FOV: 45 degrees · 2048 by 1536 pixels: 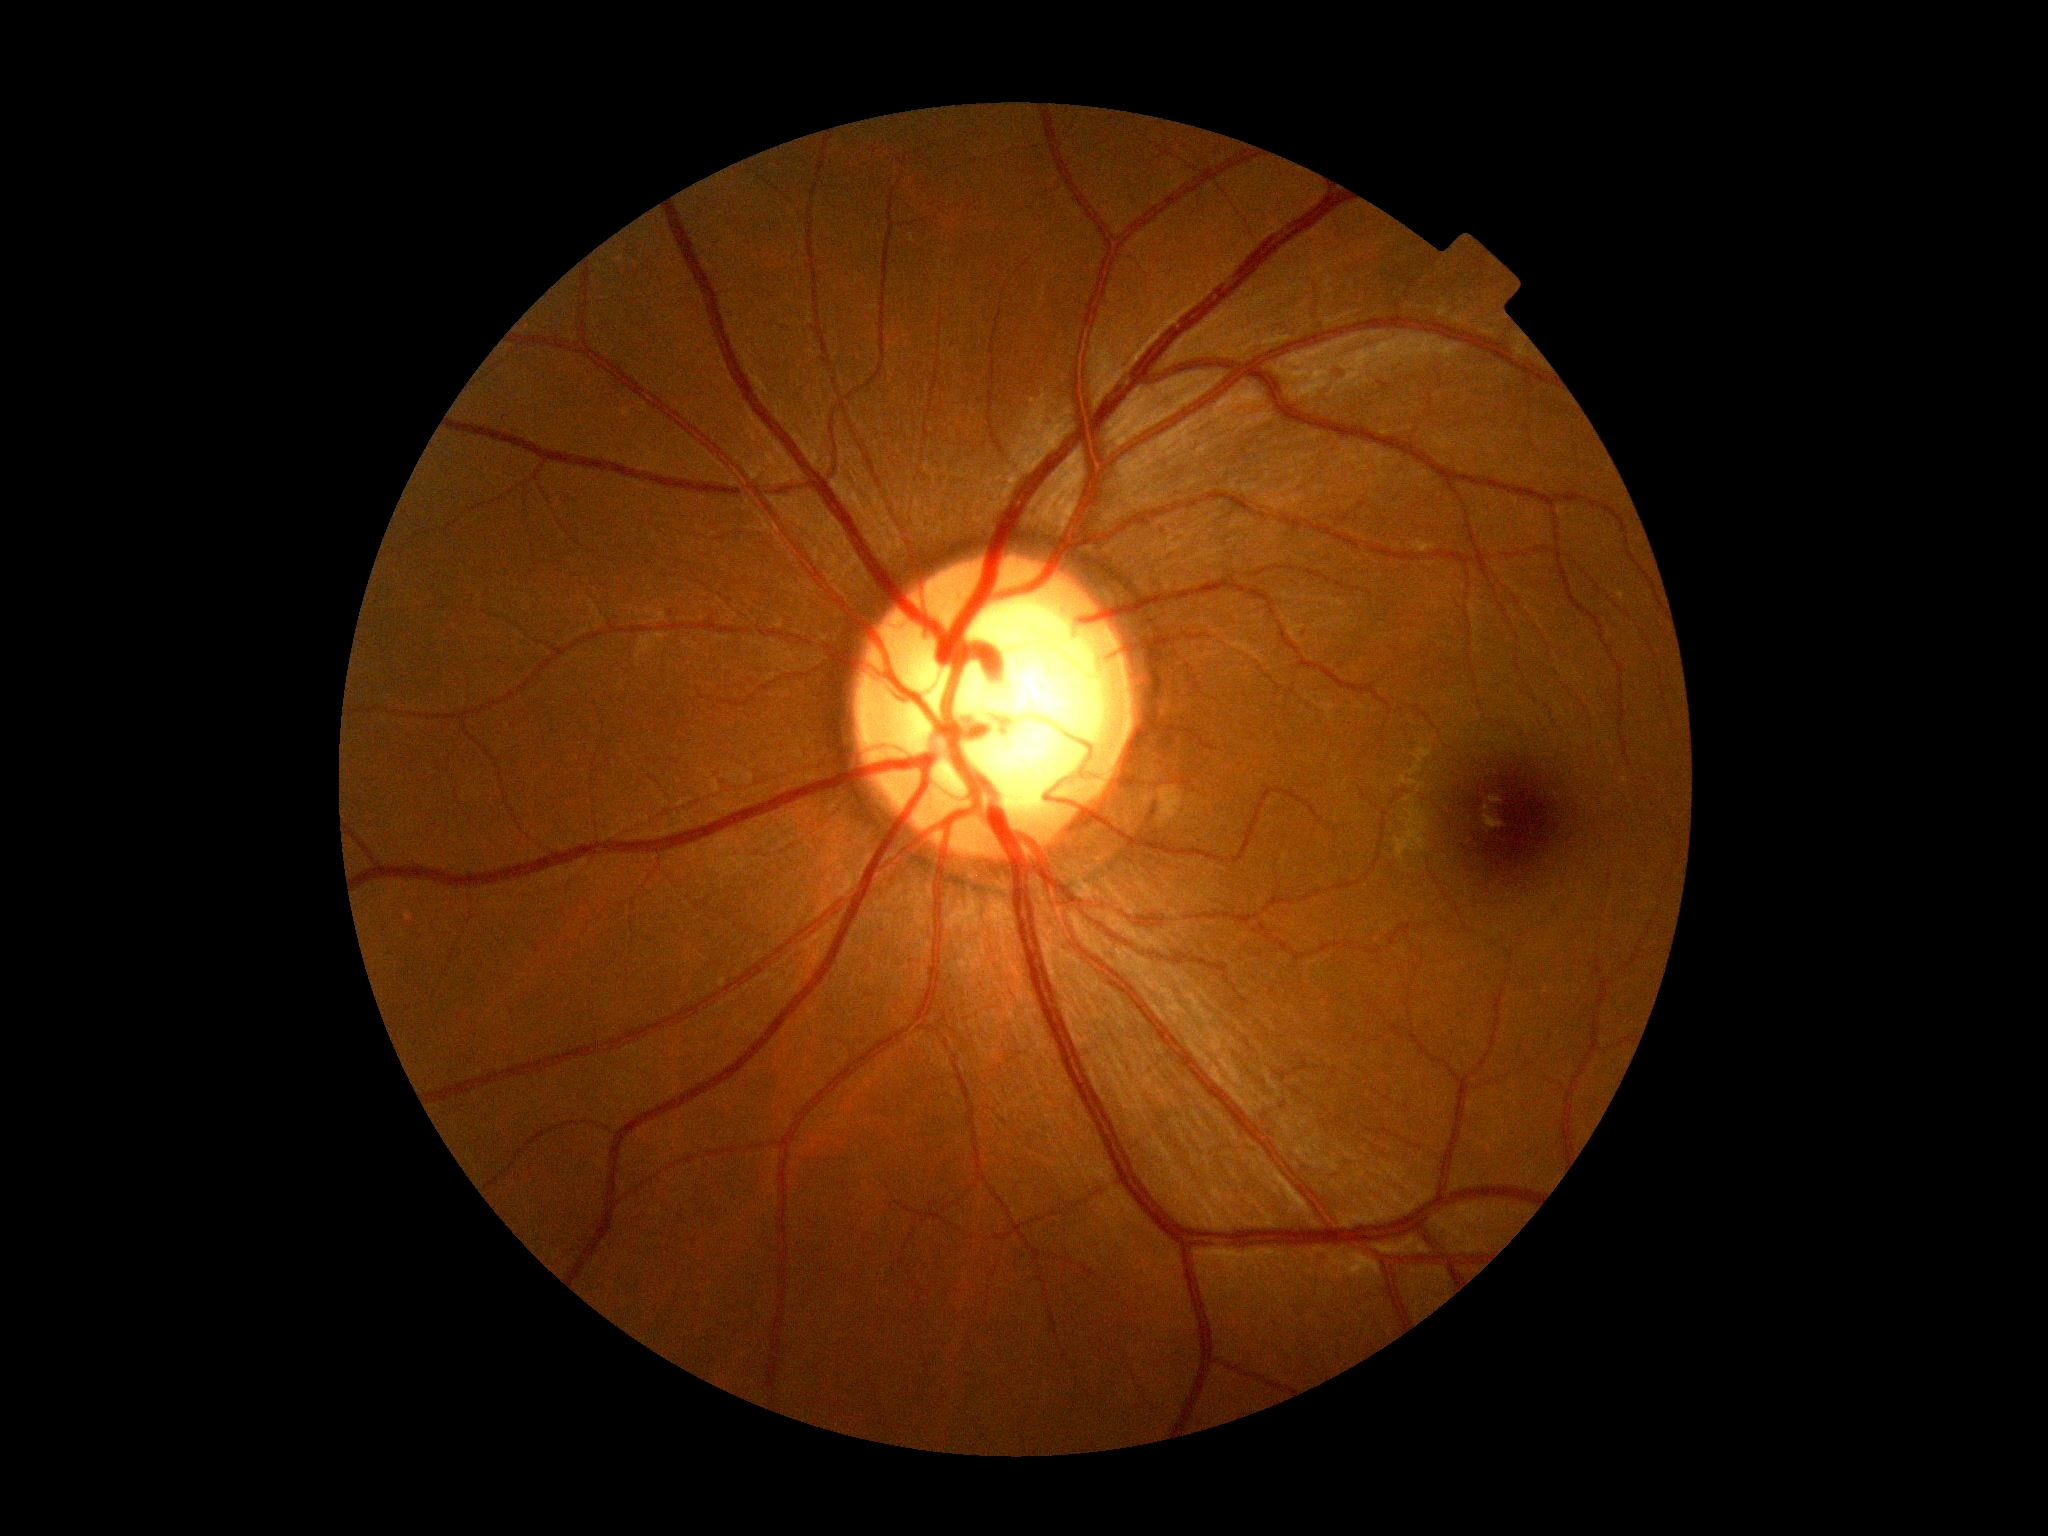
No DR findings. DR severity is grade 0.